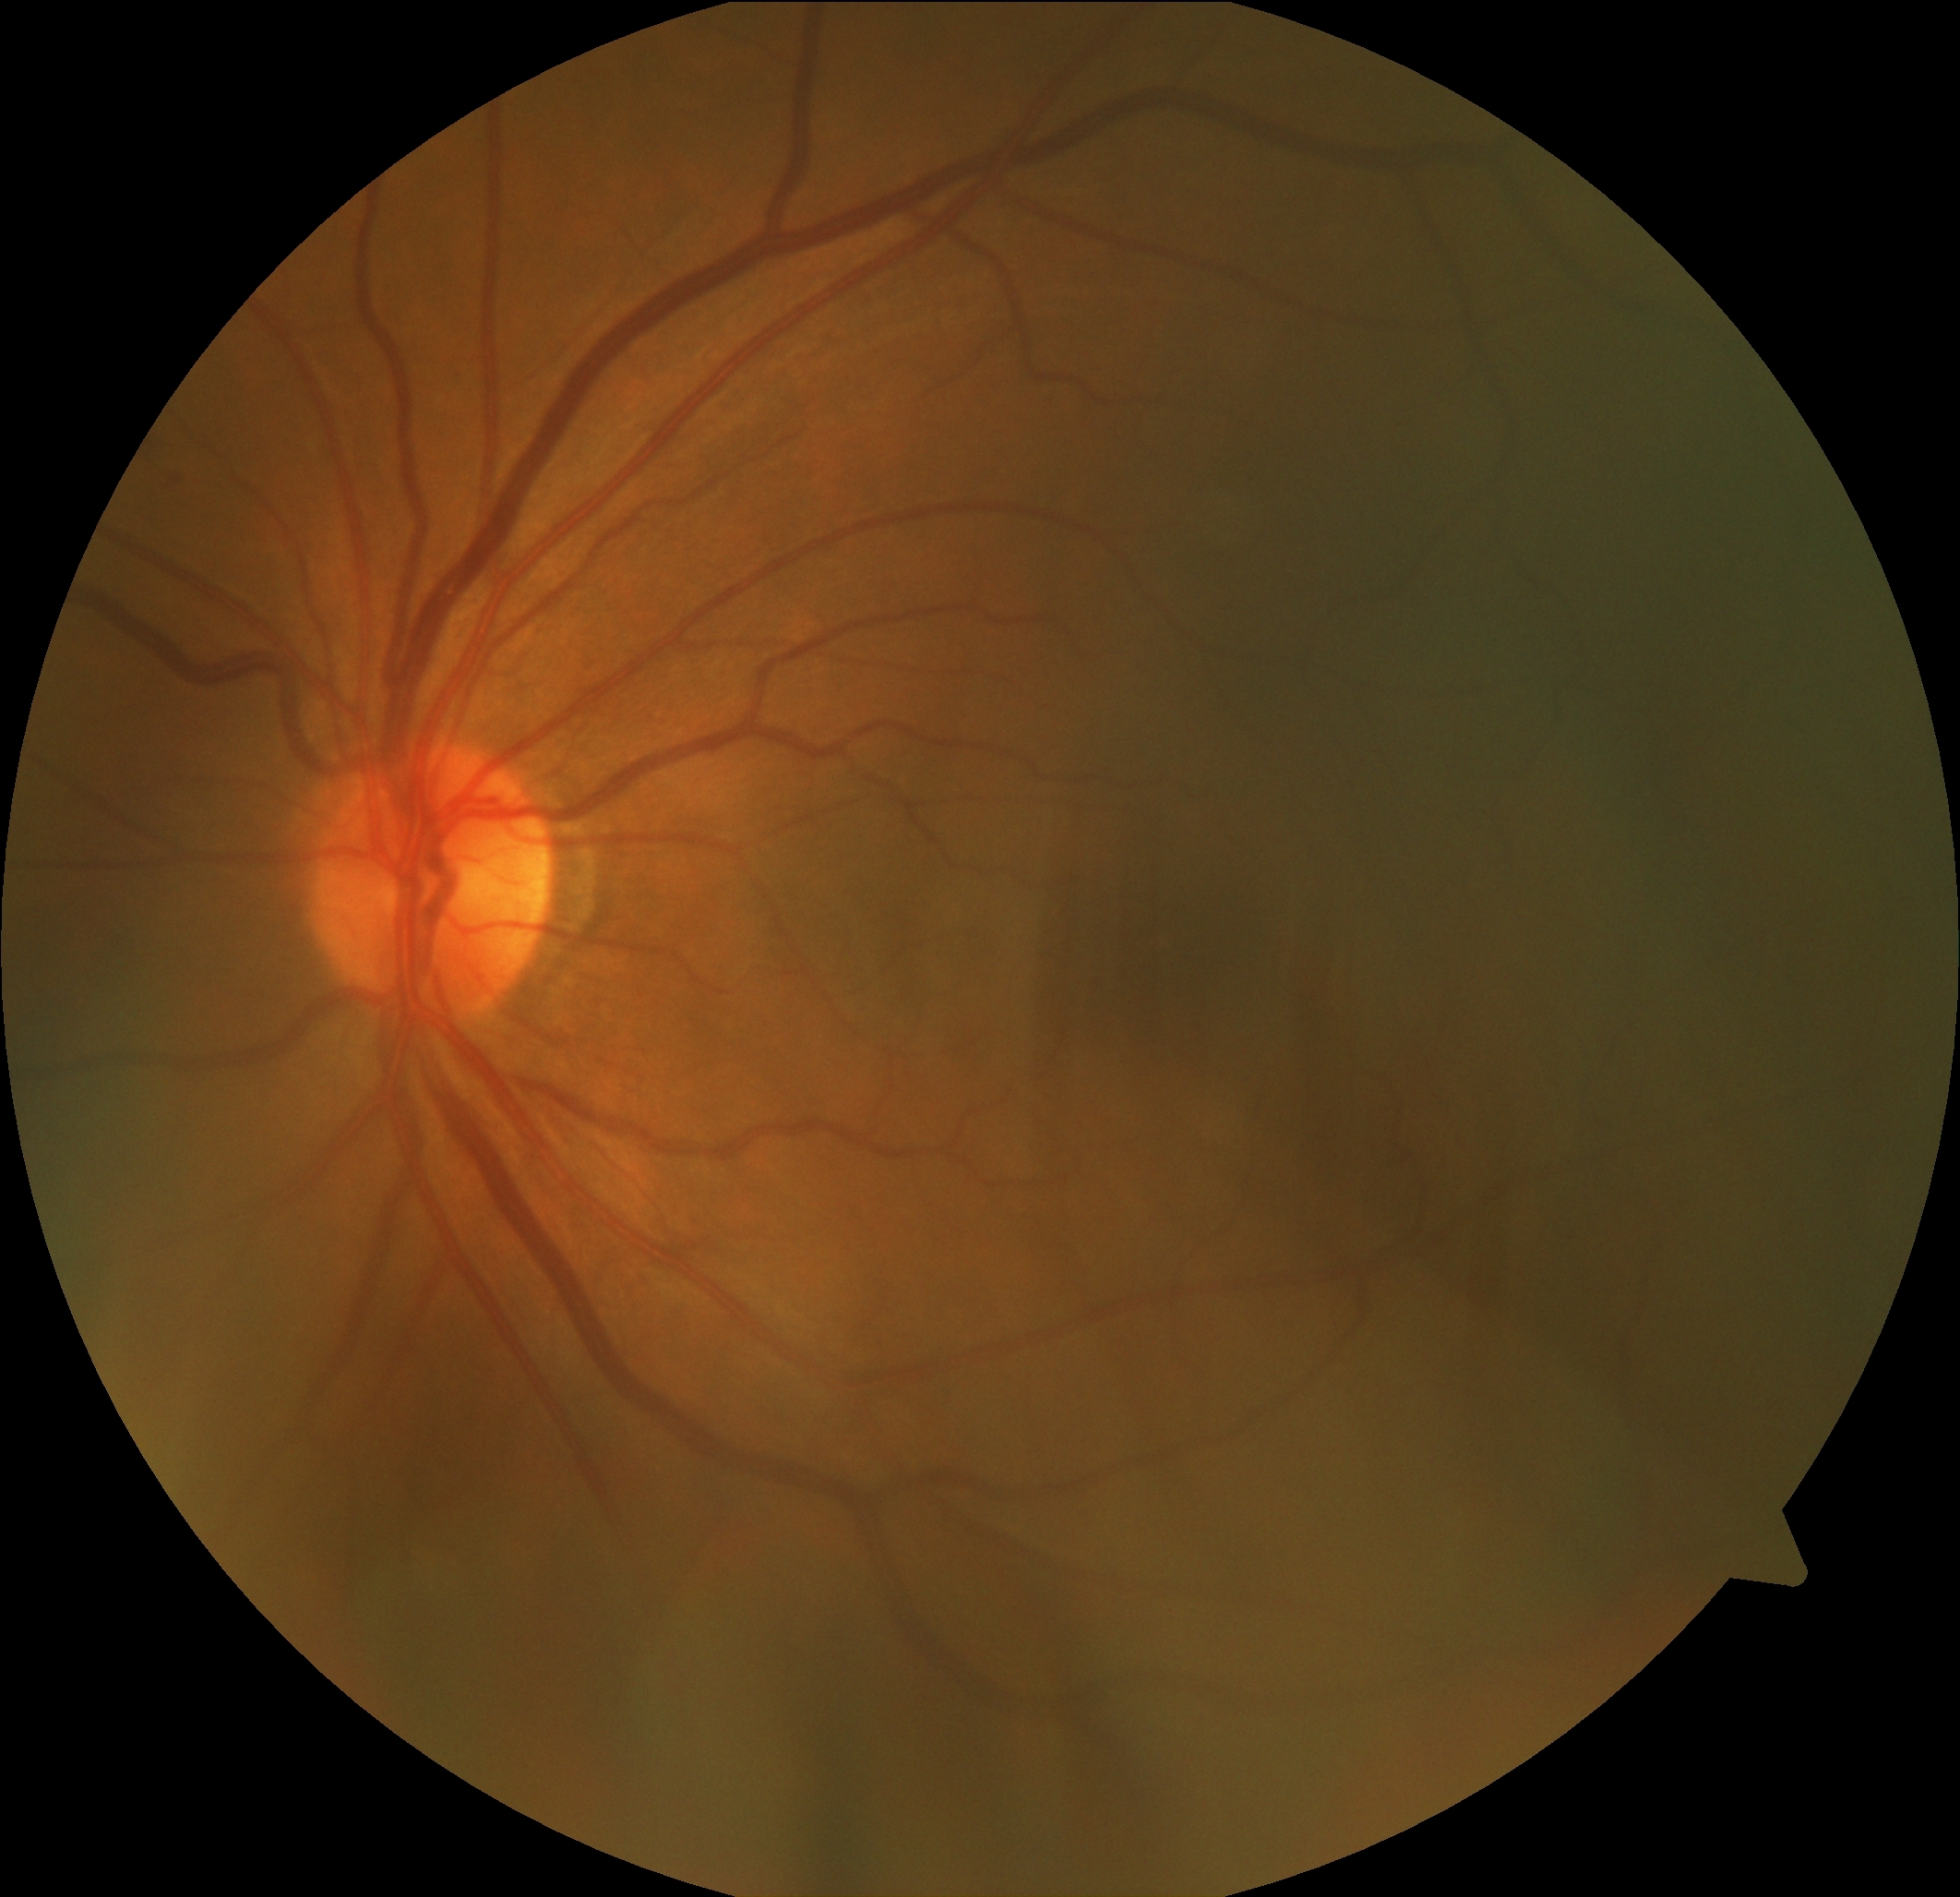

DR: no apparent retinopathy (grade 0). No apparent diabetic retinopathy.